Wide-field retinal mosaic image:
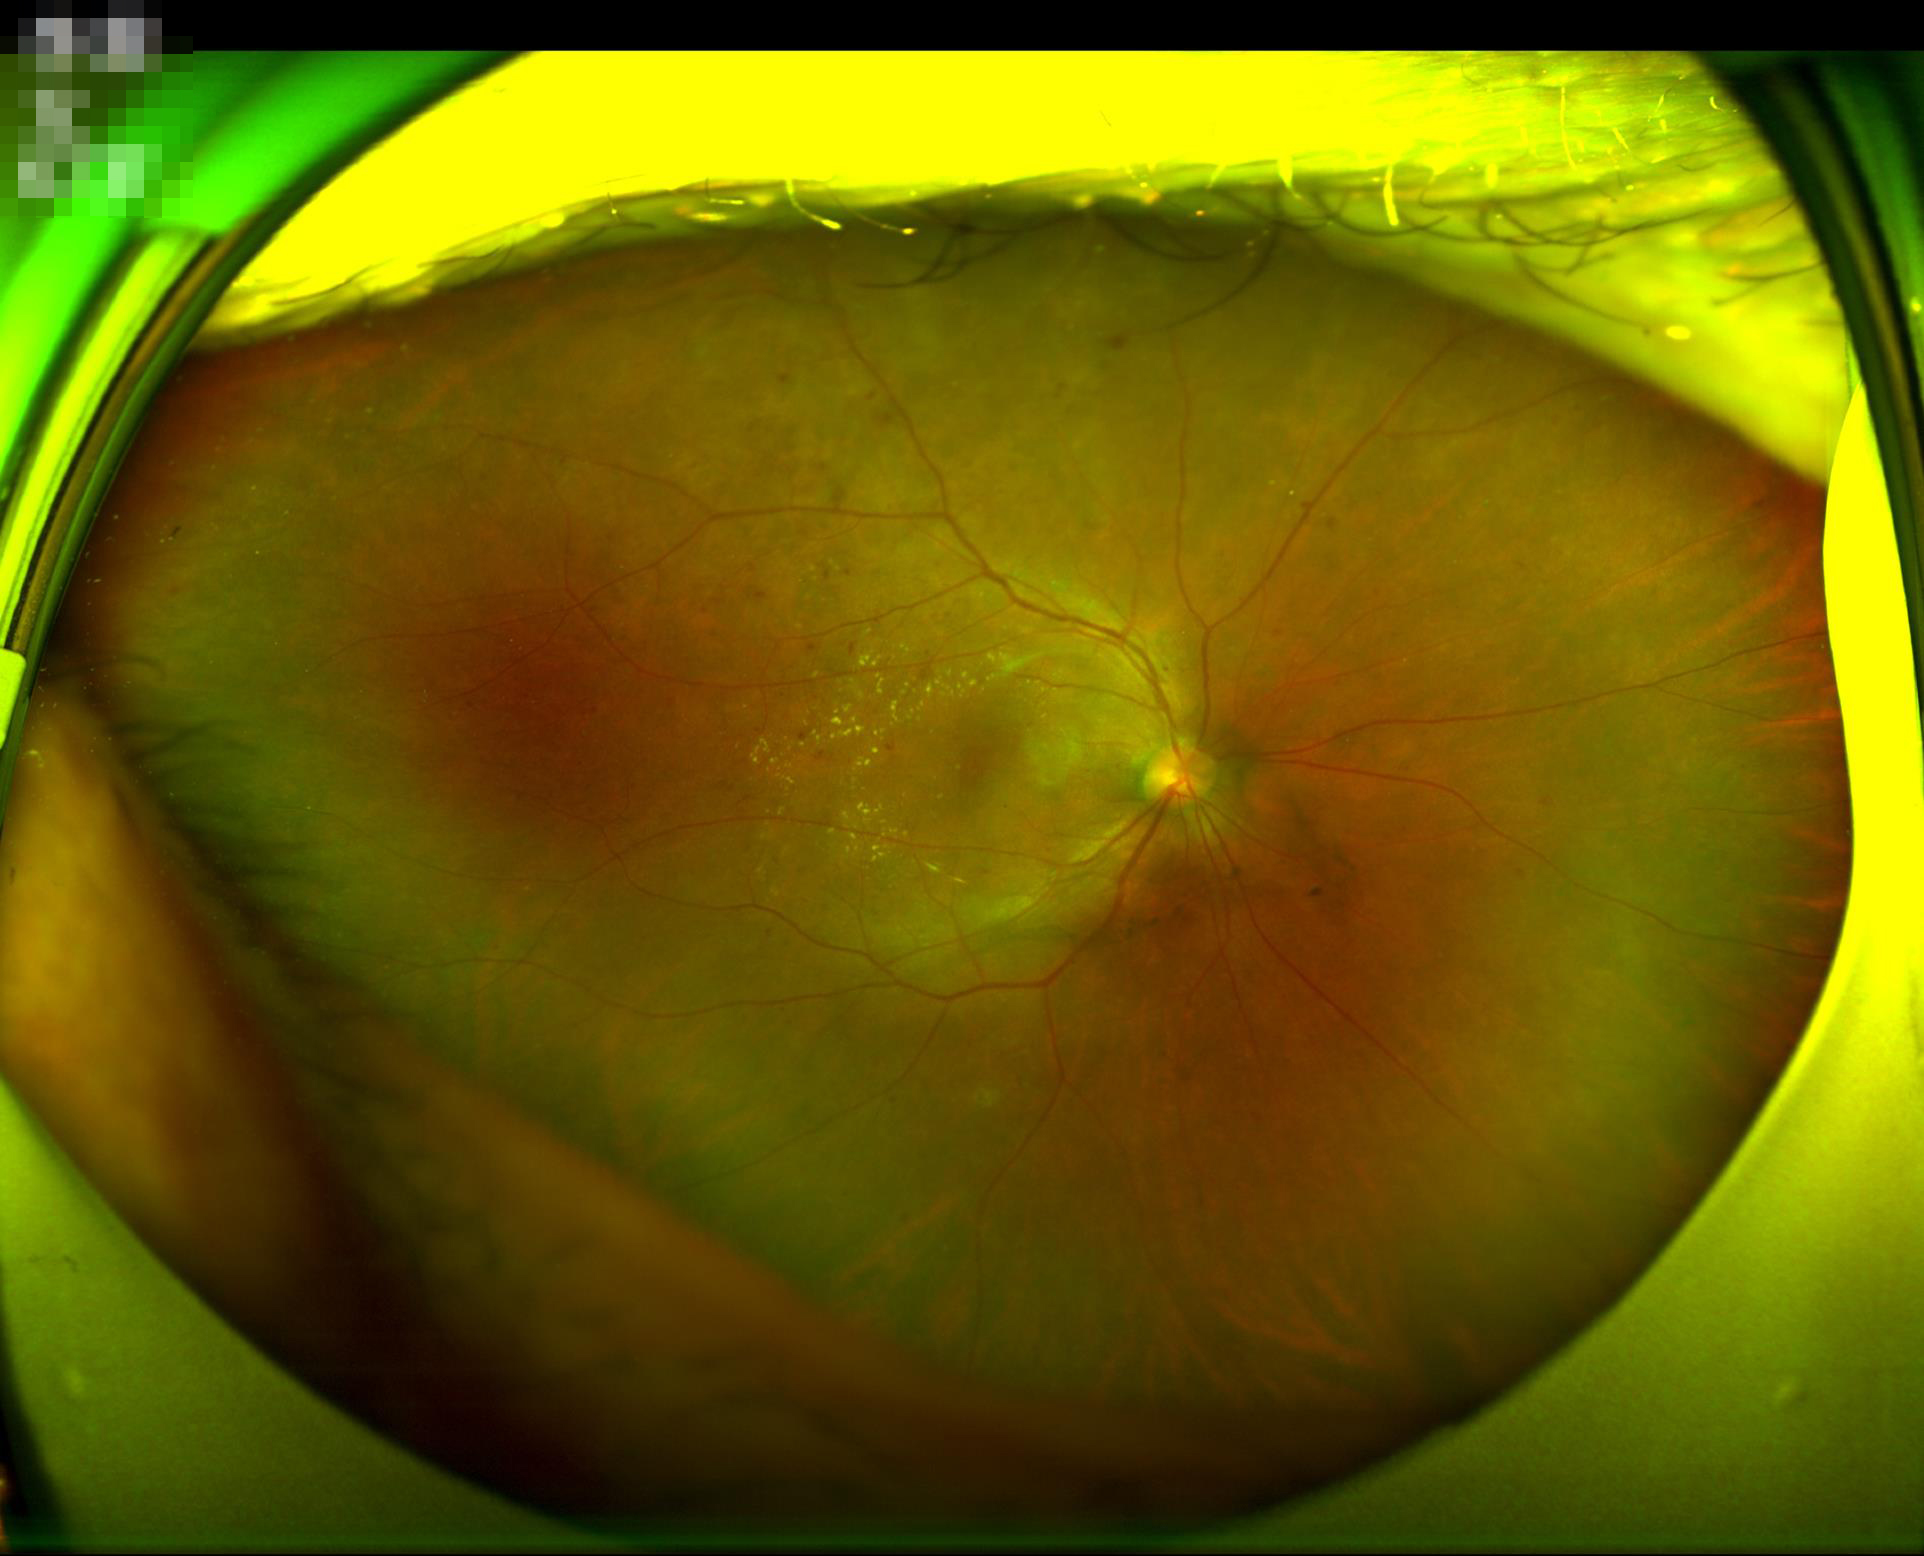
Overall image quality: good and suitable for diagnostic use | Illumination/color: uniform, no color cast | Contrast: vessels and details readily distinguishable | Clarity: clear with no noticeable blur.